Color fundus photograph — 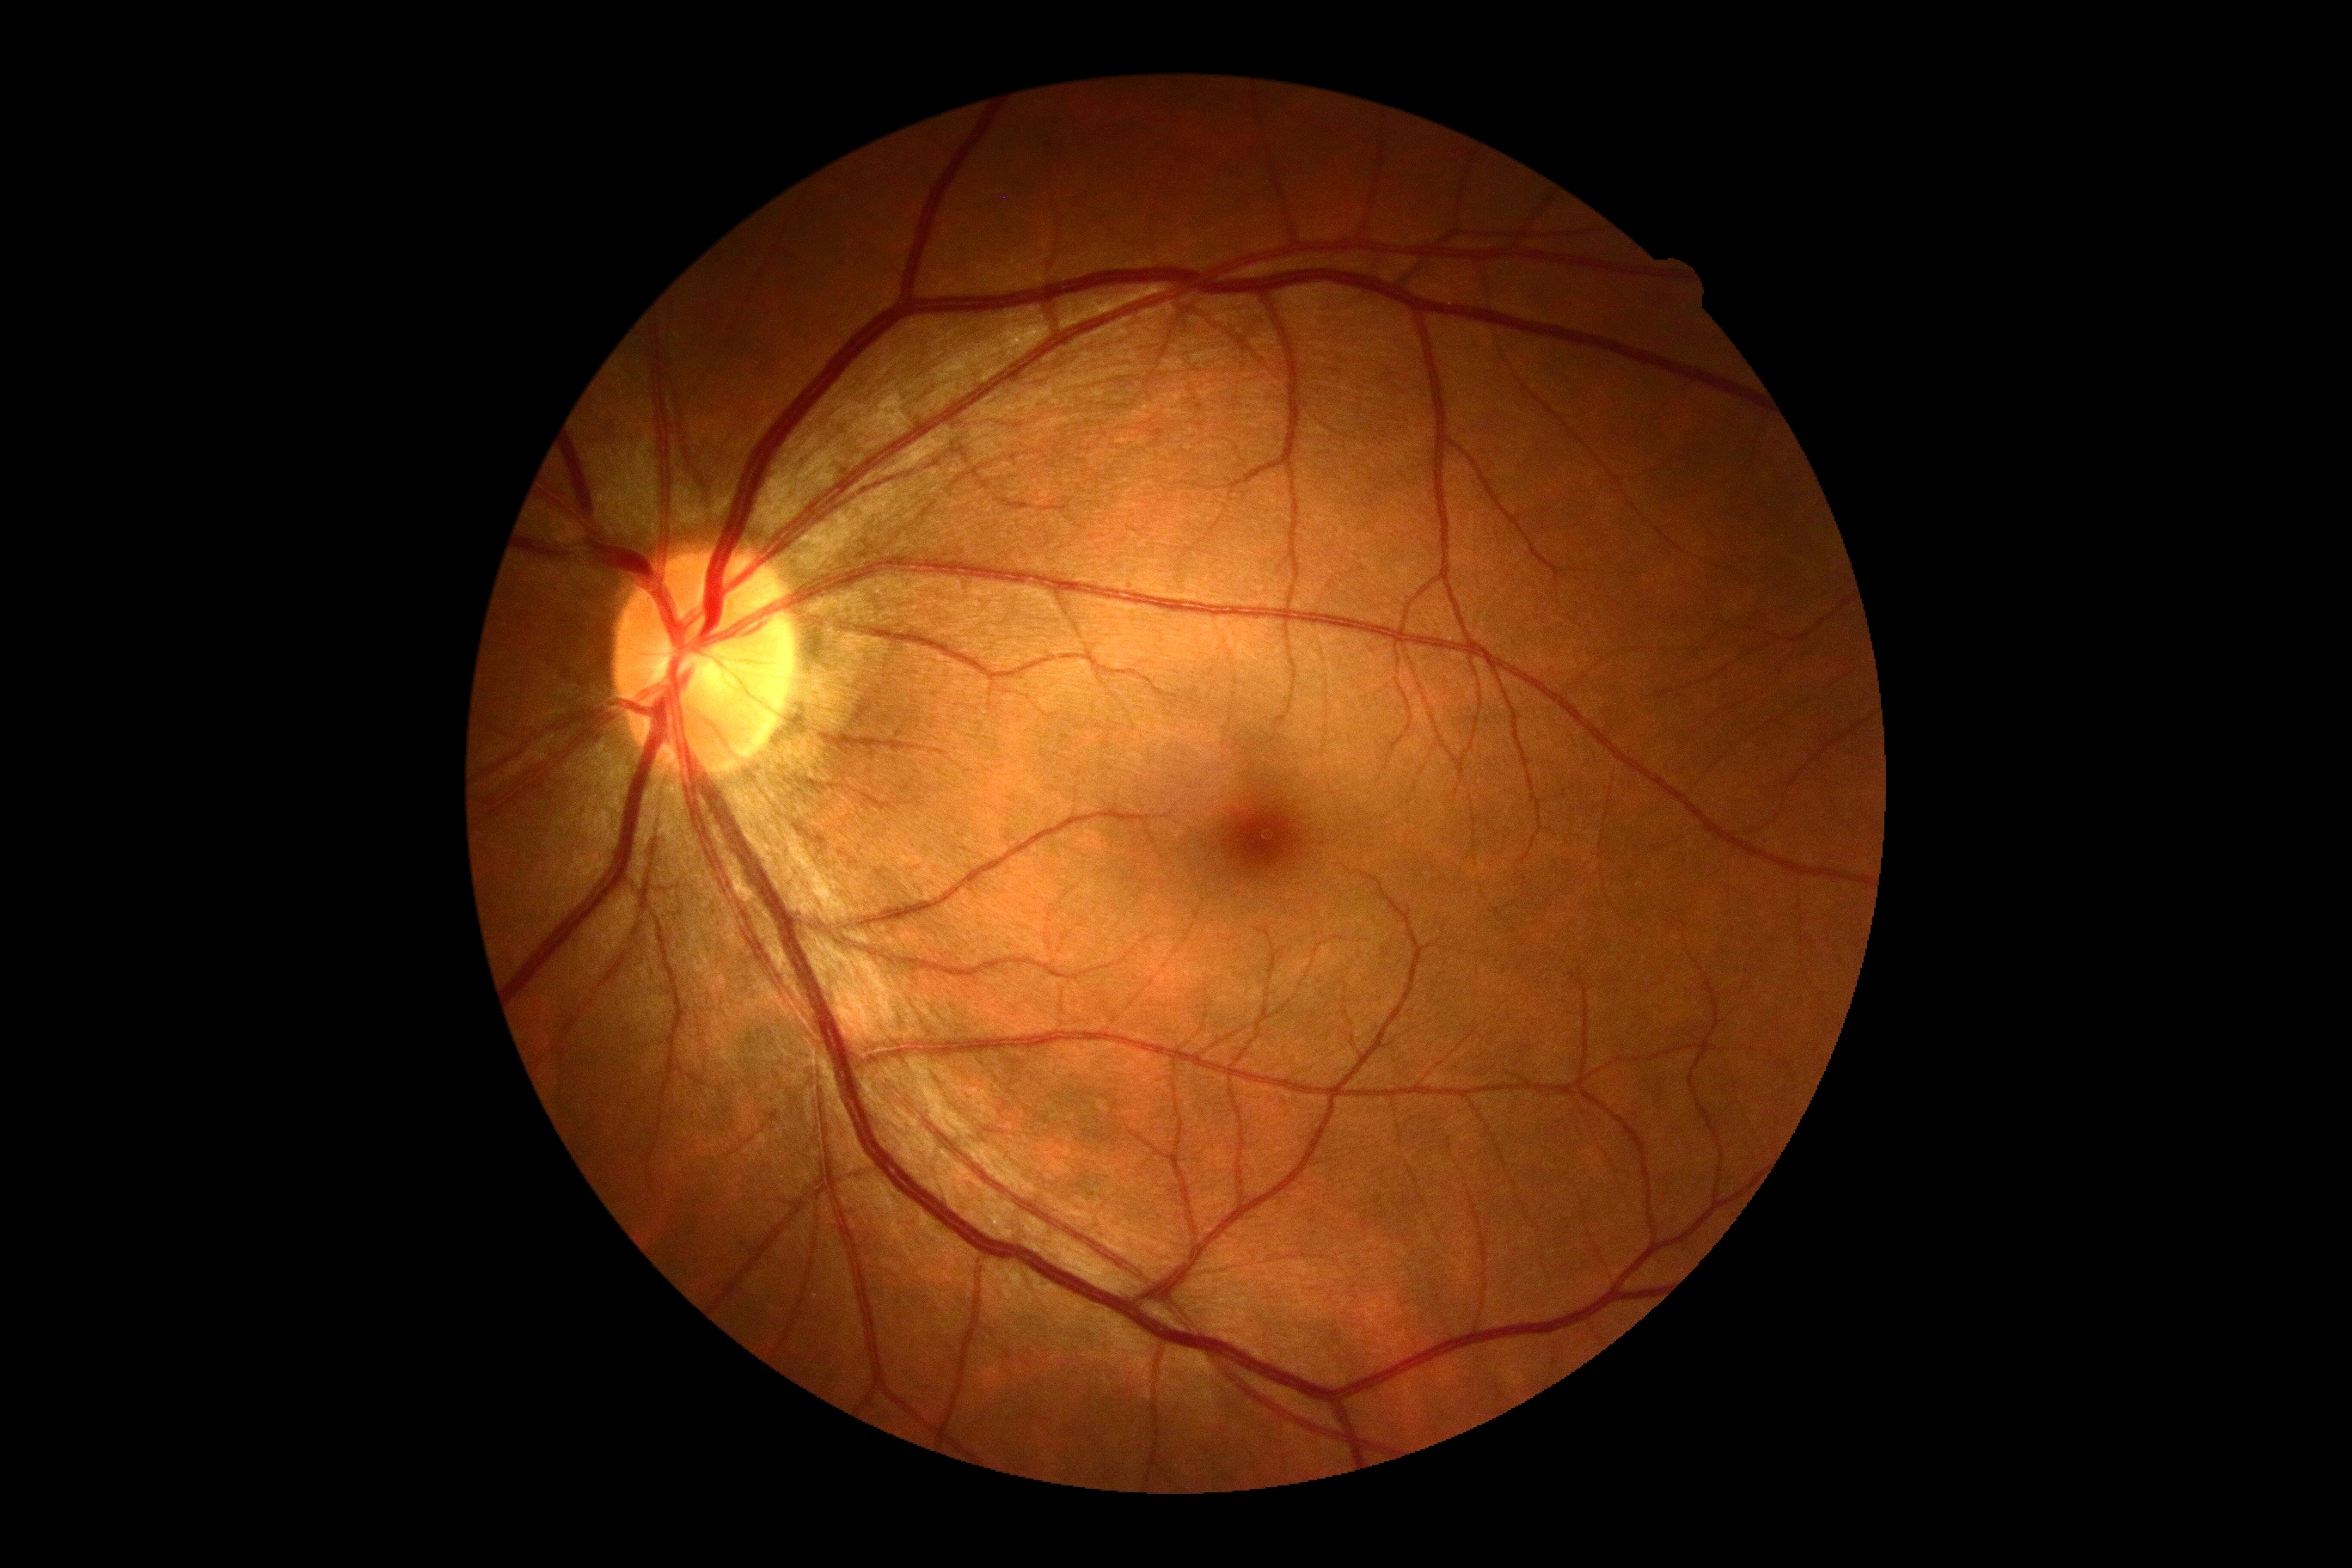 Diabetic retinopathy grade is 0 (no apparent retinopathy).